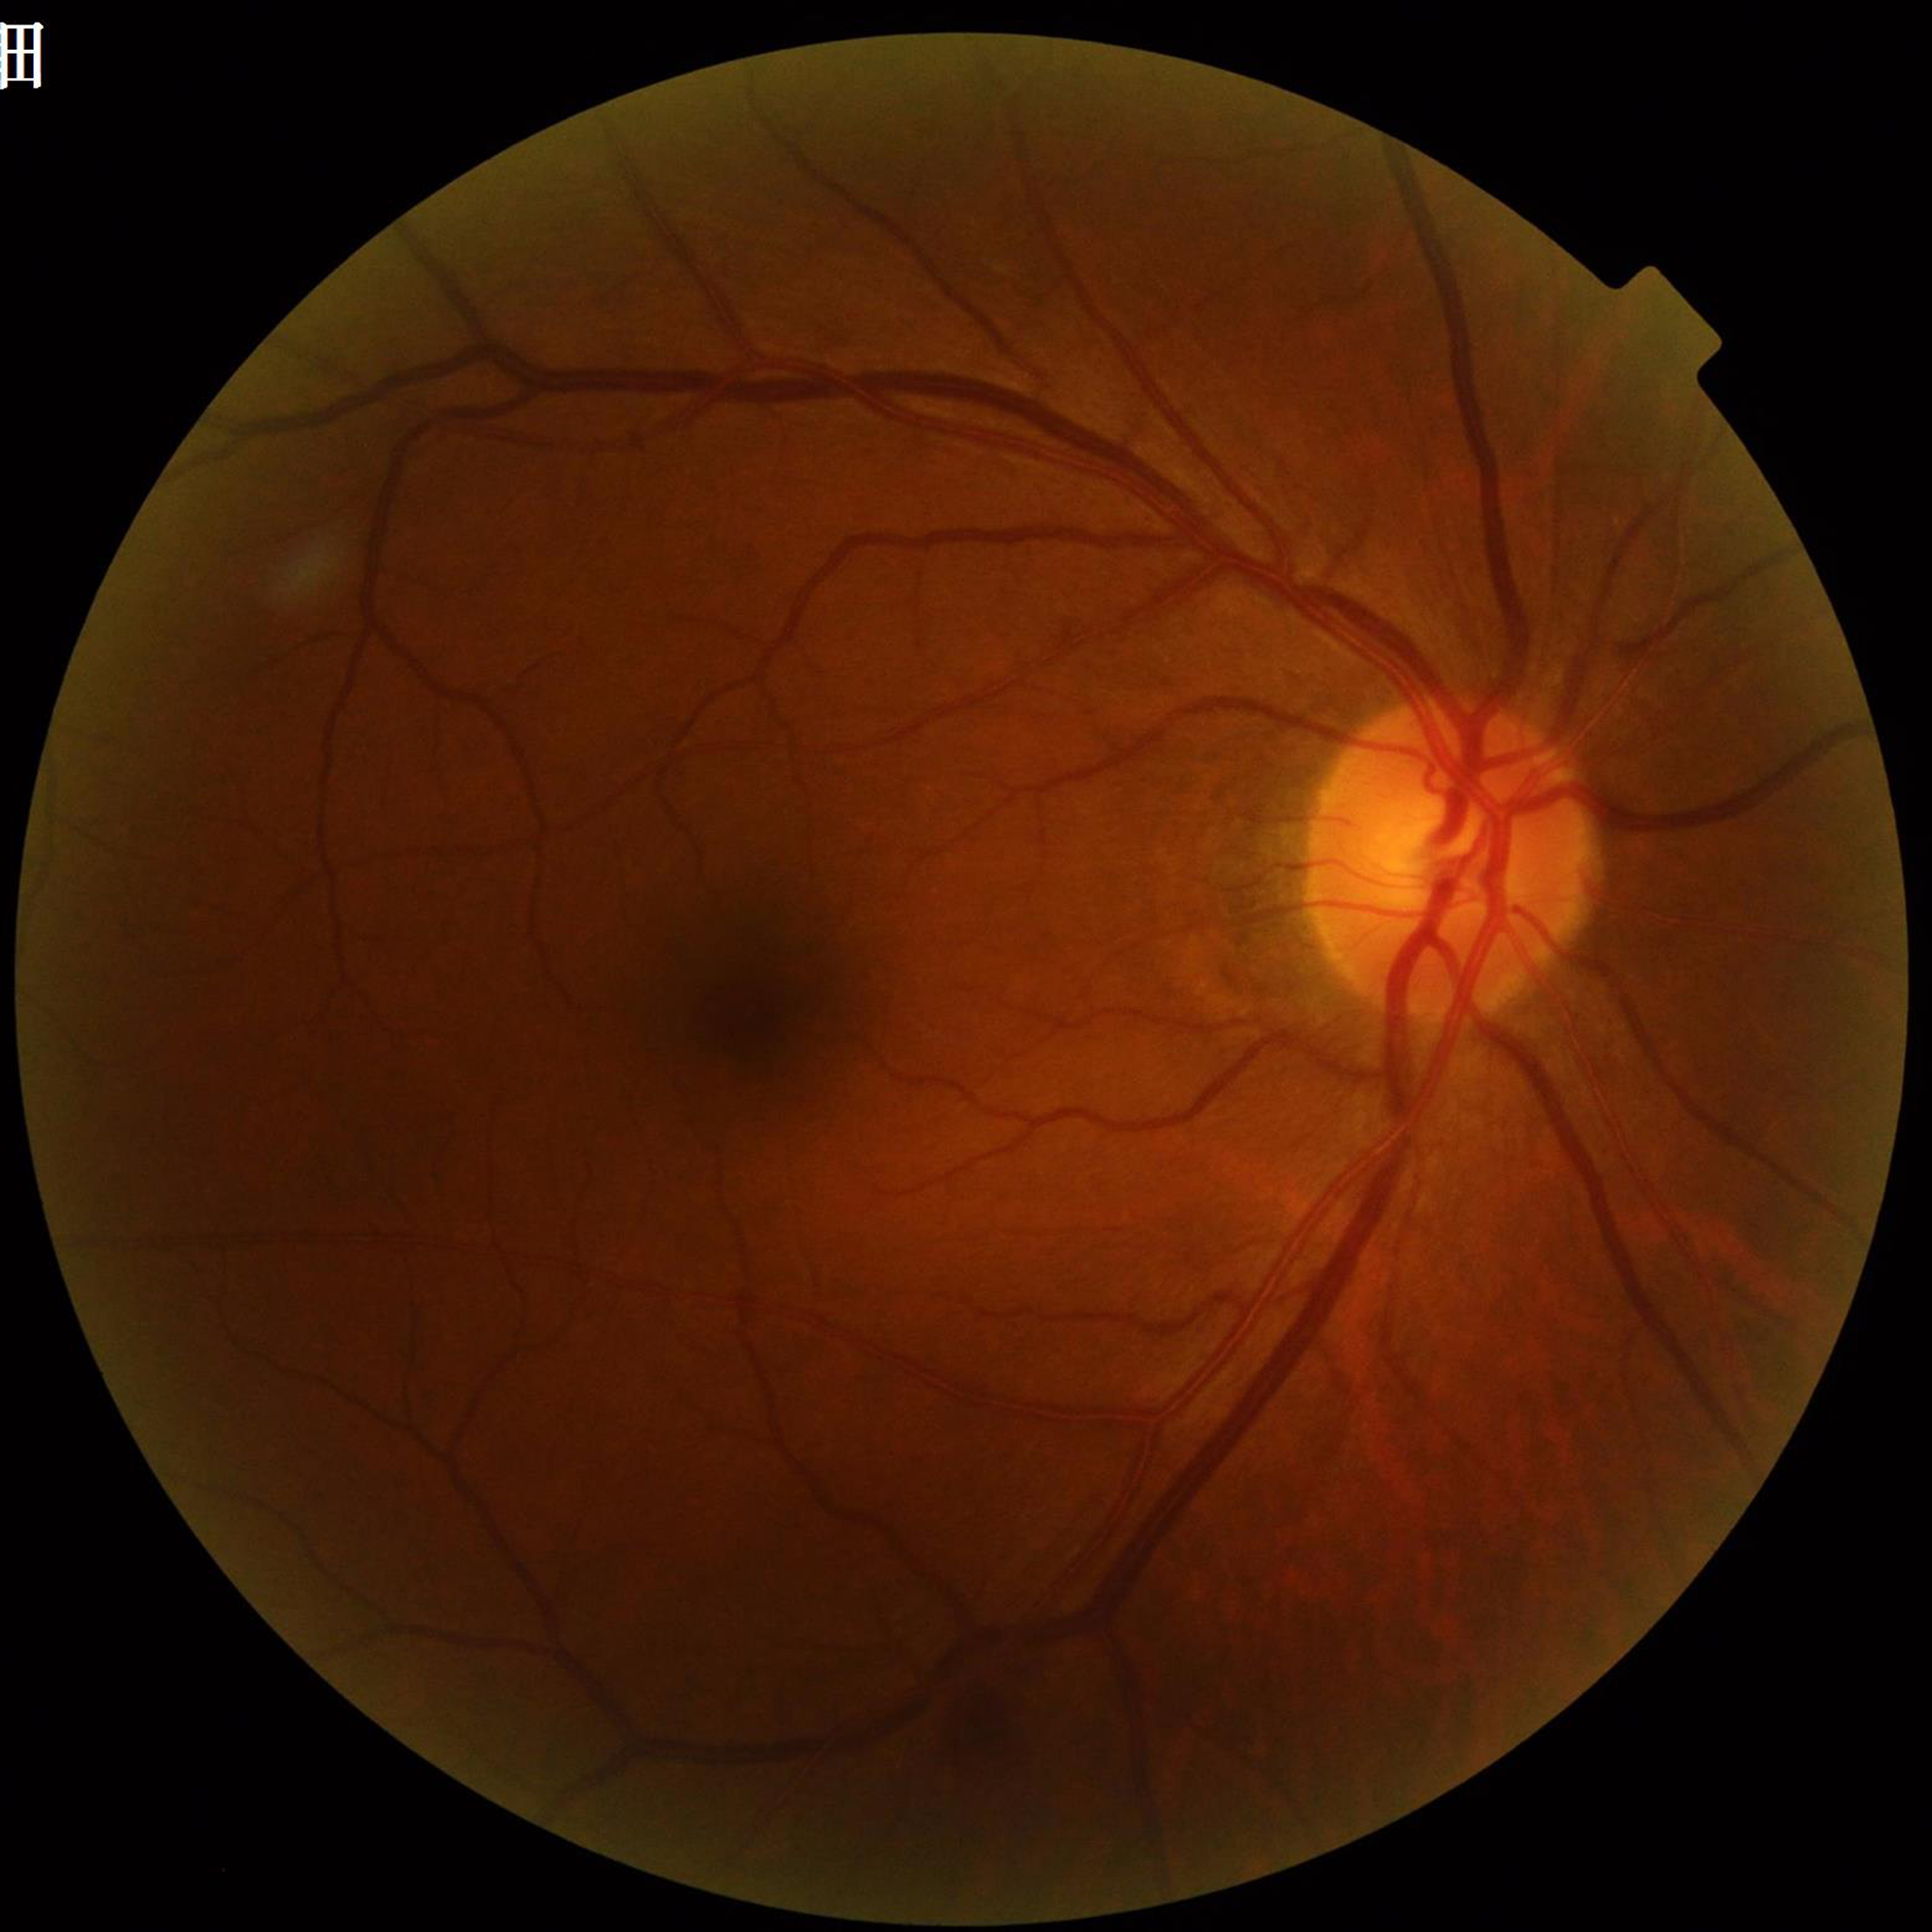 Image quality: illumination and color satisfactory, no blur, contrast adequate
Impression: diabetic retinopathy